Acquired with a NIDEK AFC-230, 45° field of view, without pupil dilation.
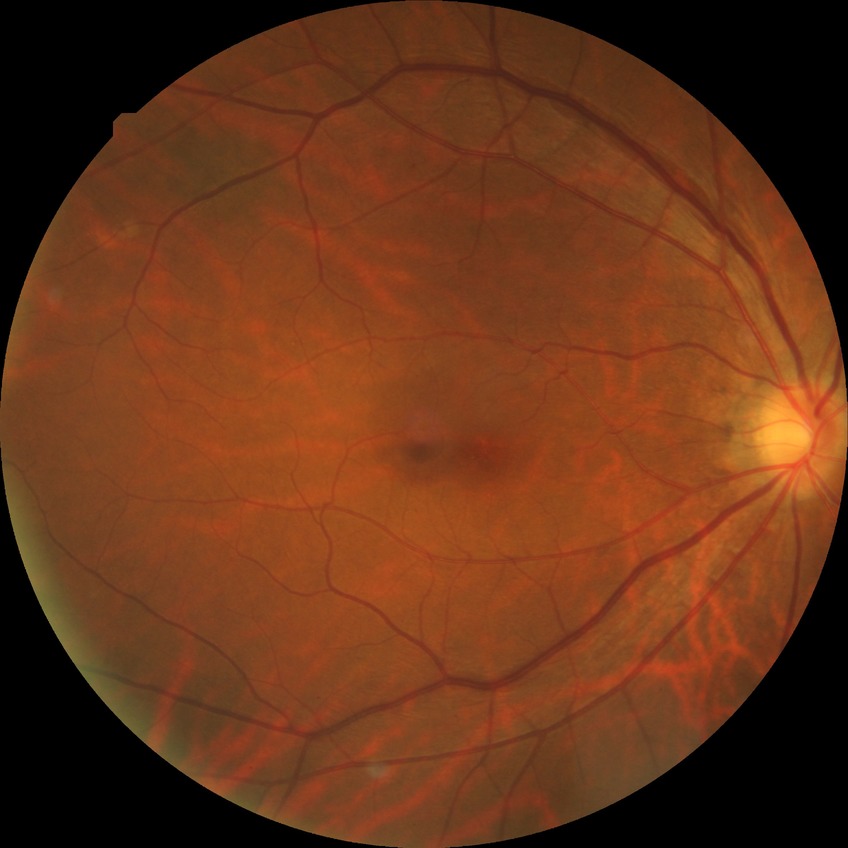

Davis grading is no diabetic retinopathy.